Image size 640x480. Acquired on the Clarity RetCam 3. Pediatric wide-field fundus photograph: 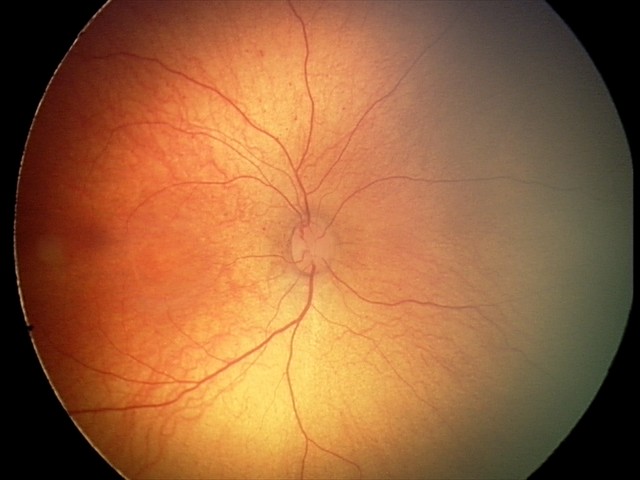

Physiological retinal appearance for postconceptual age.